Fundus photo
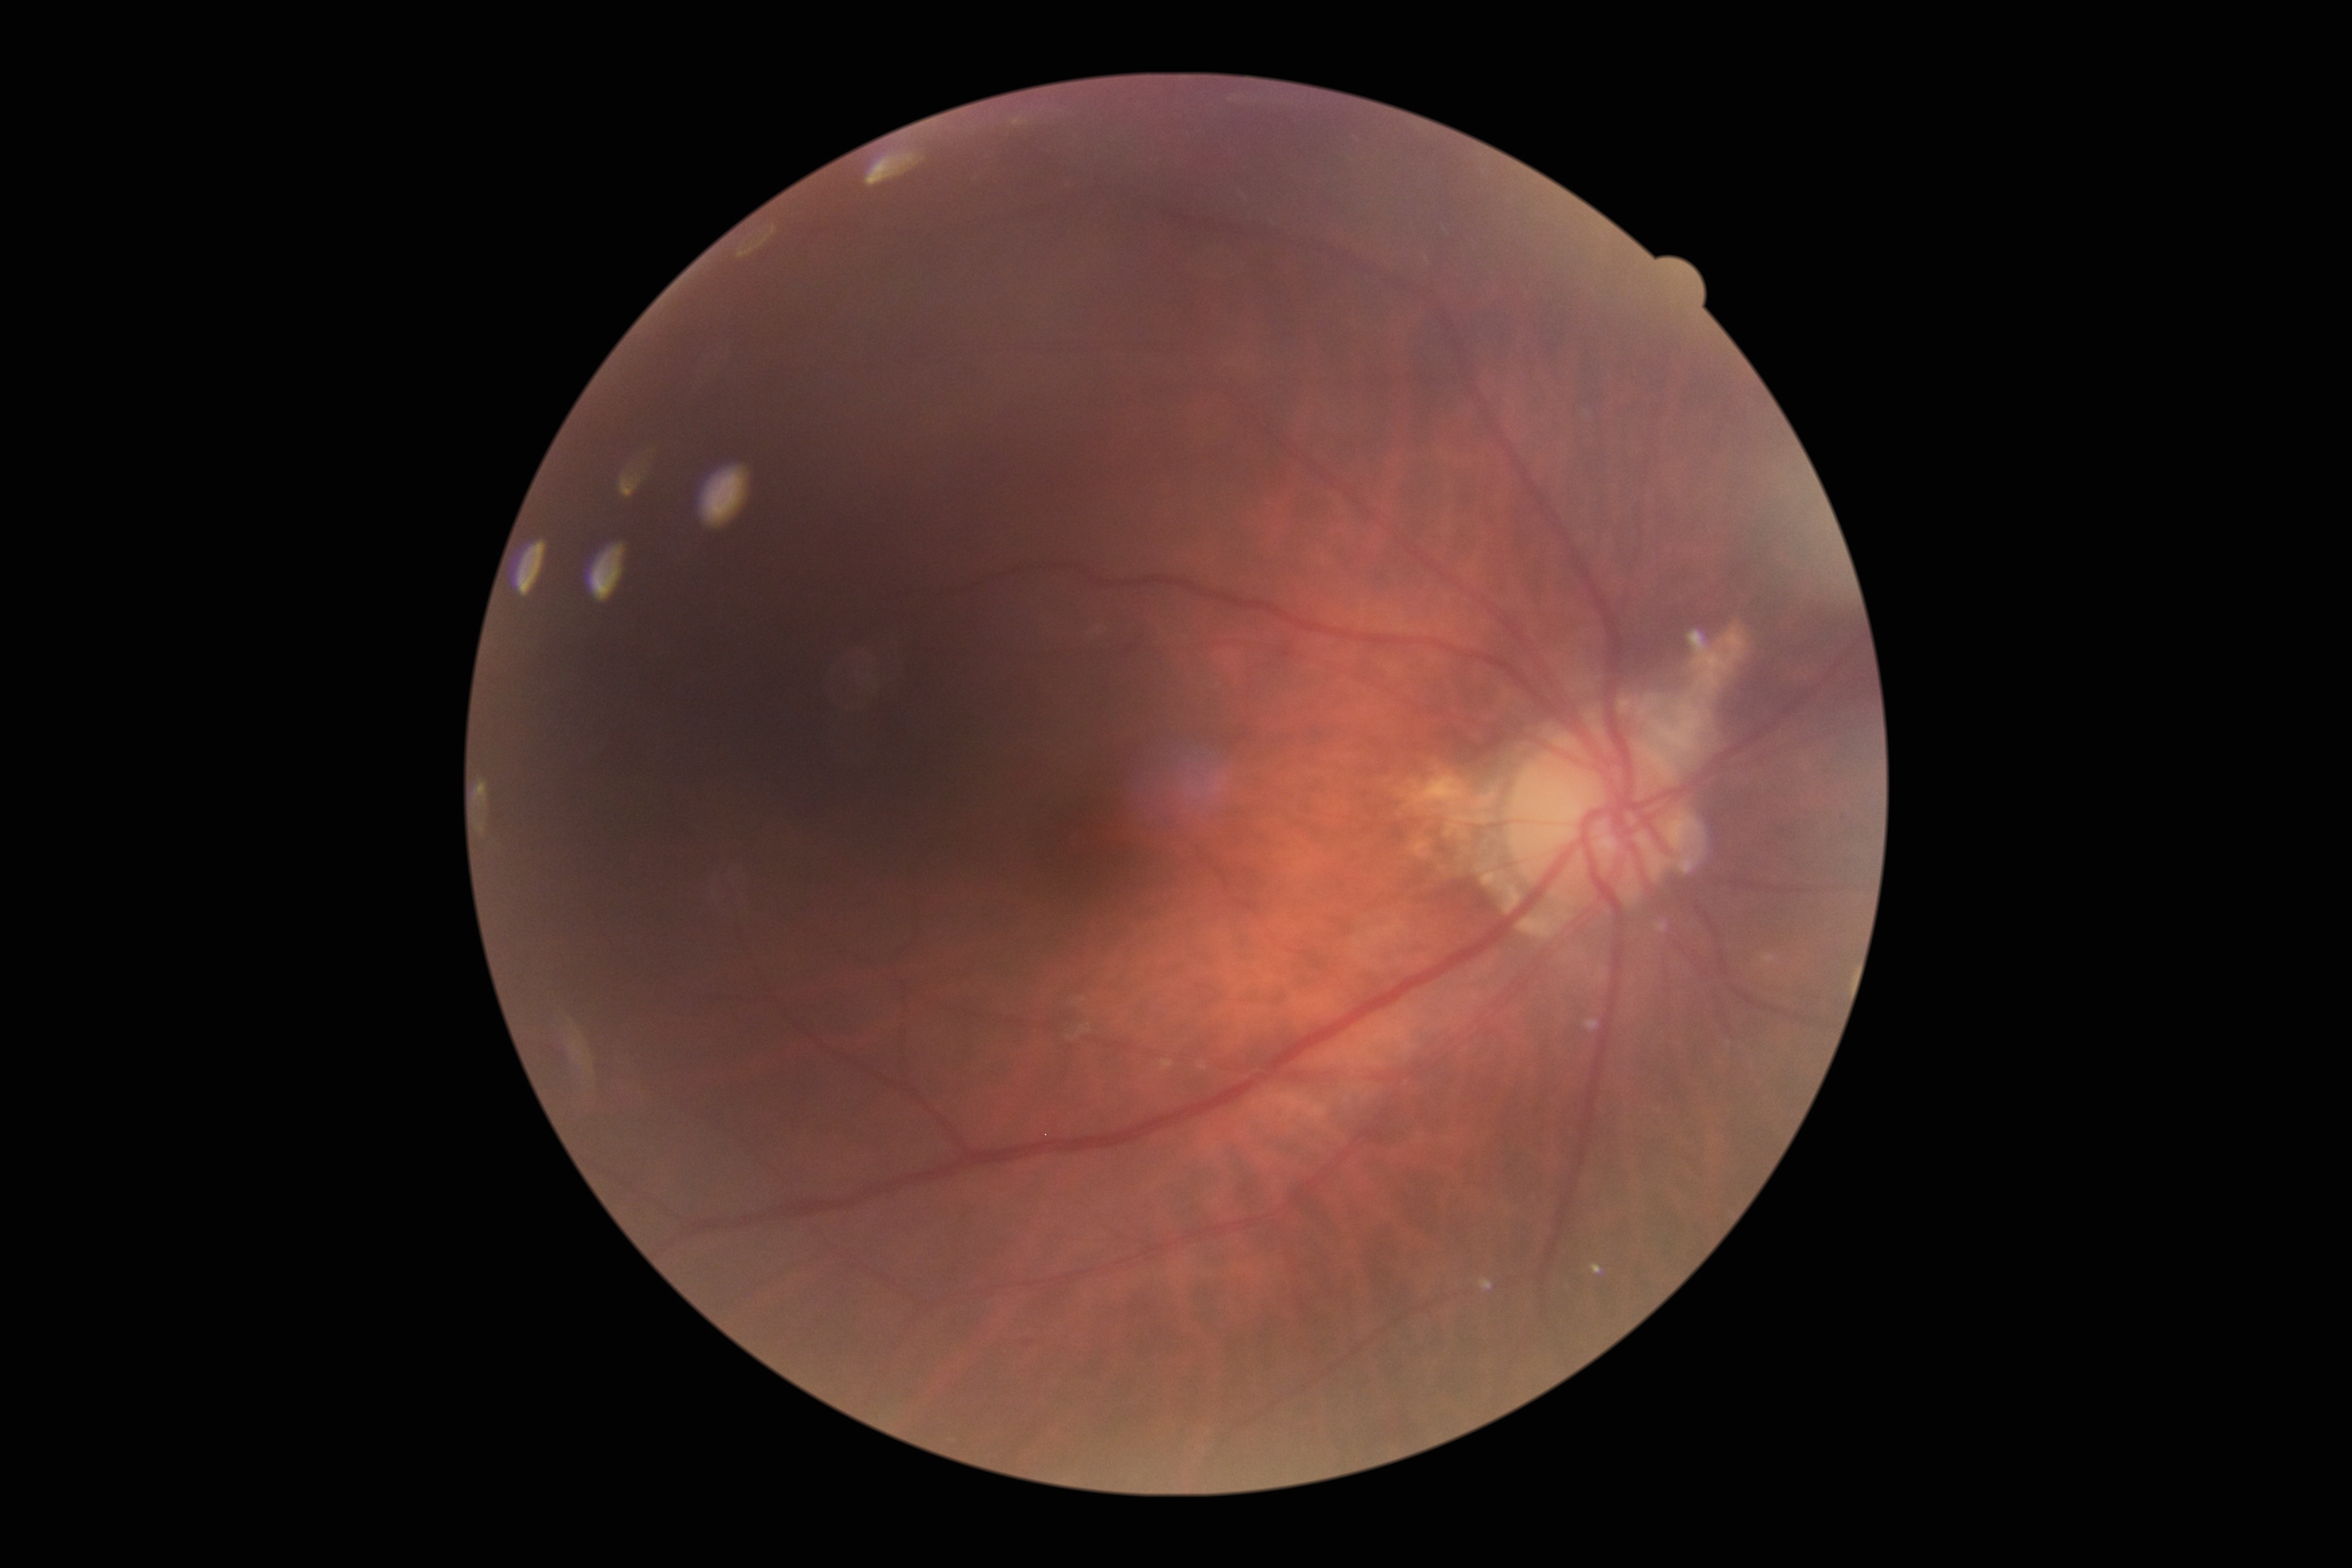

Diabetic retinopathy (DR) is 0.